Disc-centered field · color fundus photograph · non-mydriatic acquisition.
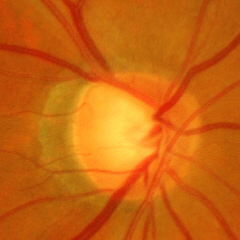 Impression = advanced glaucoma.